Macula-centered. 50° FOV — 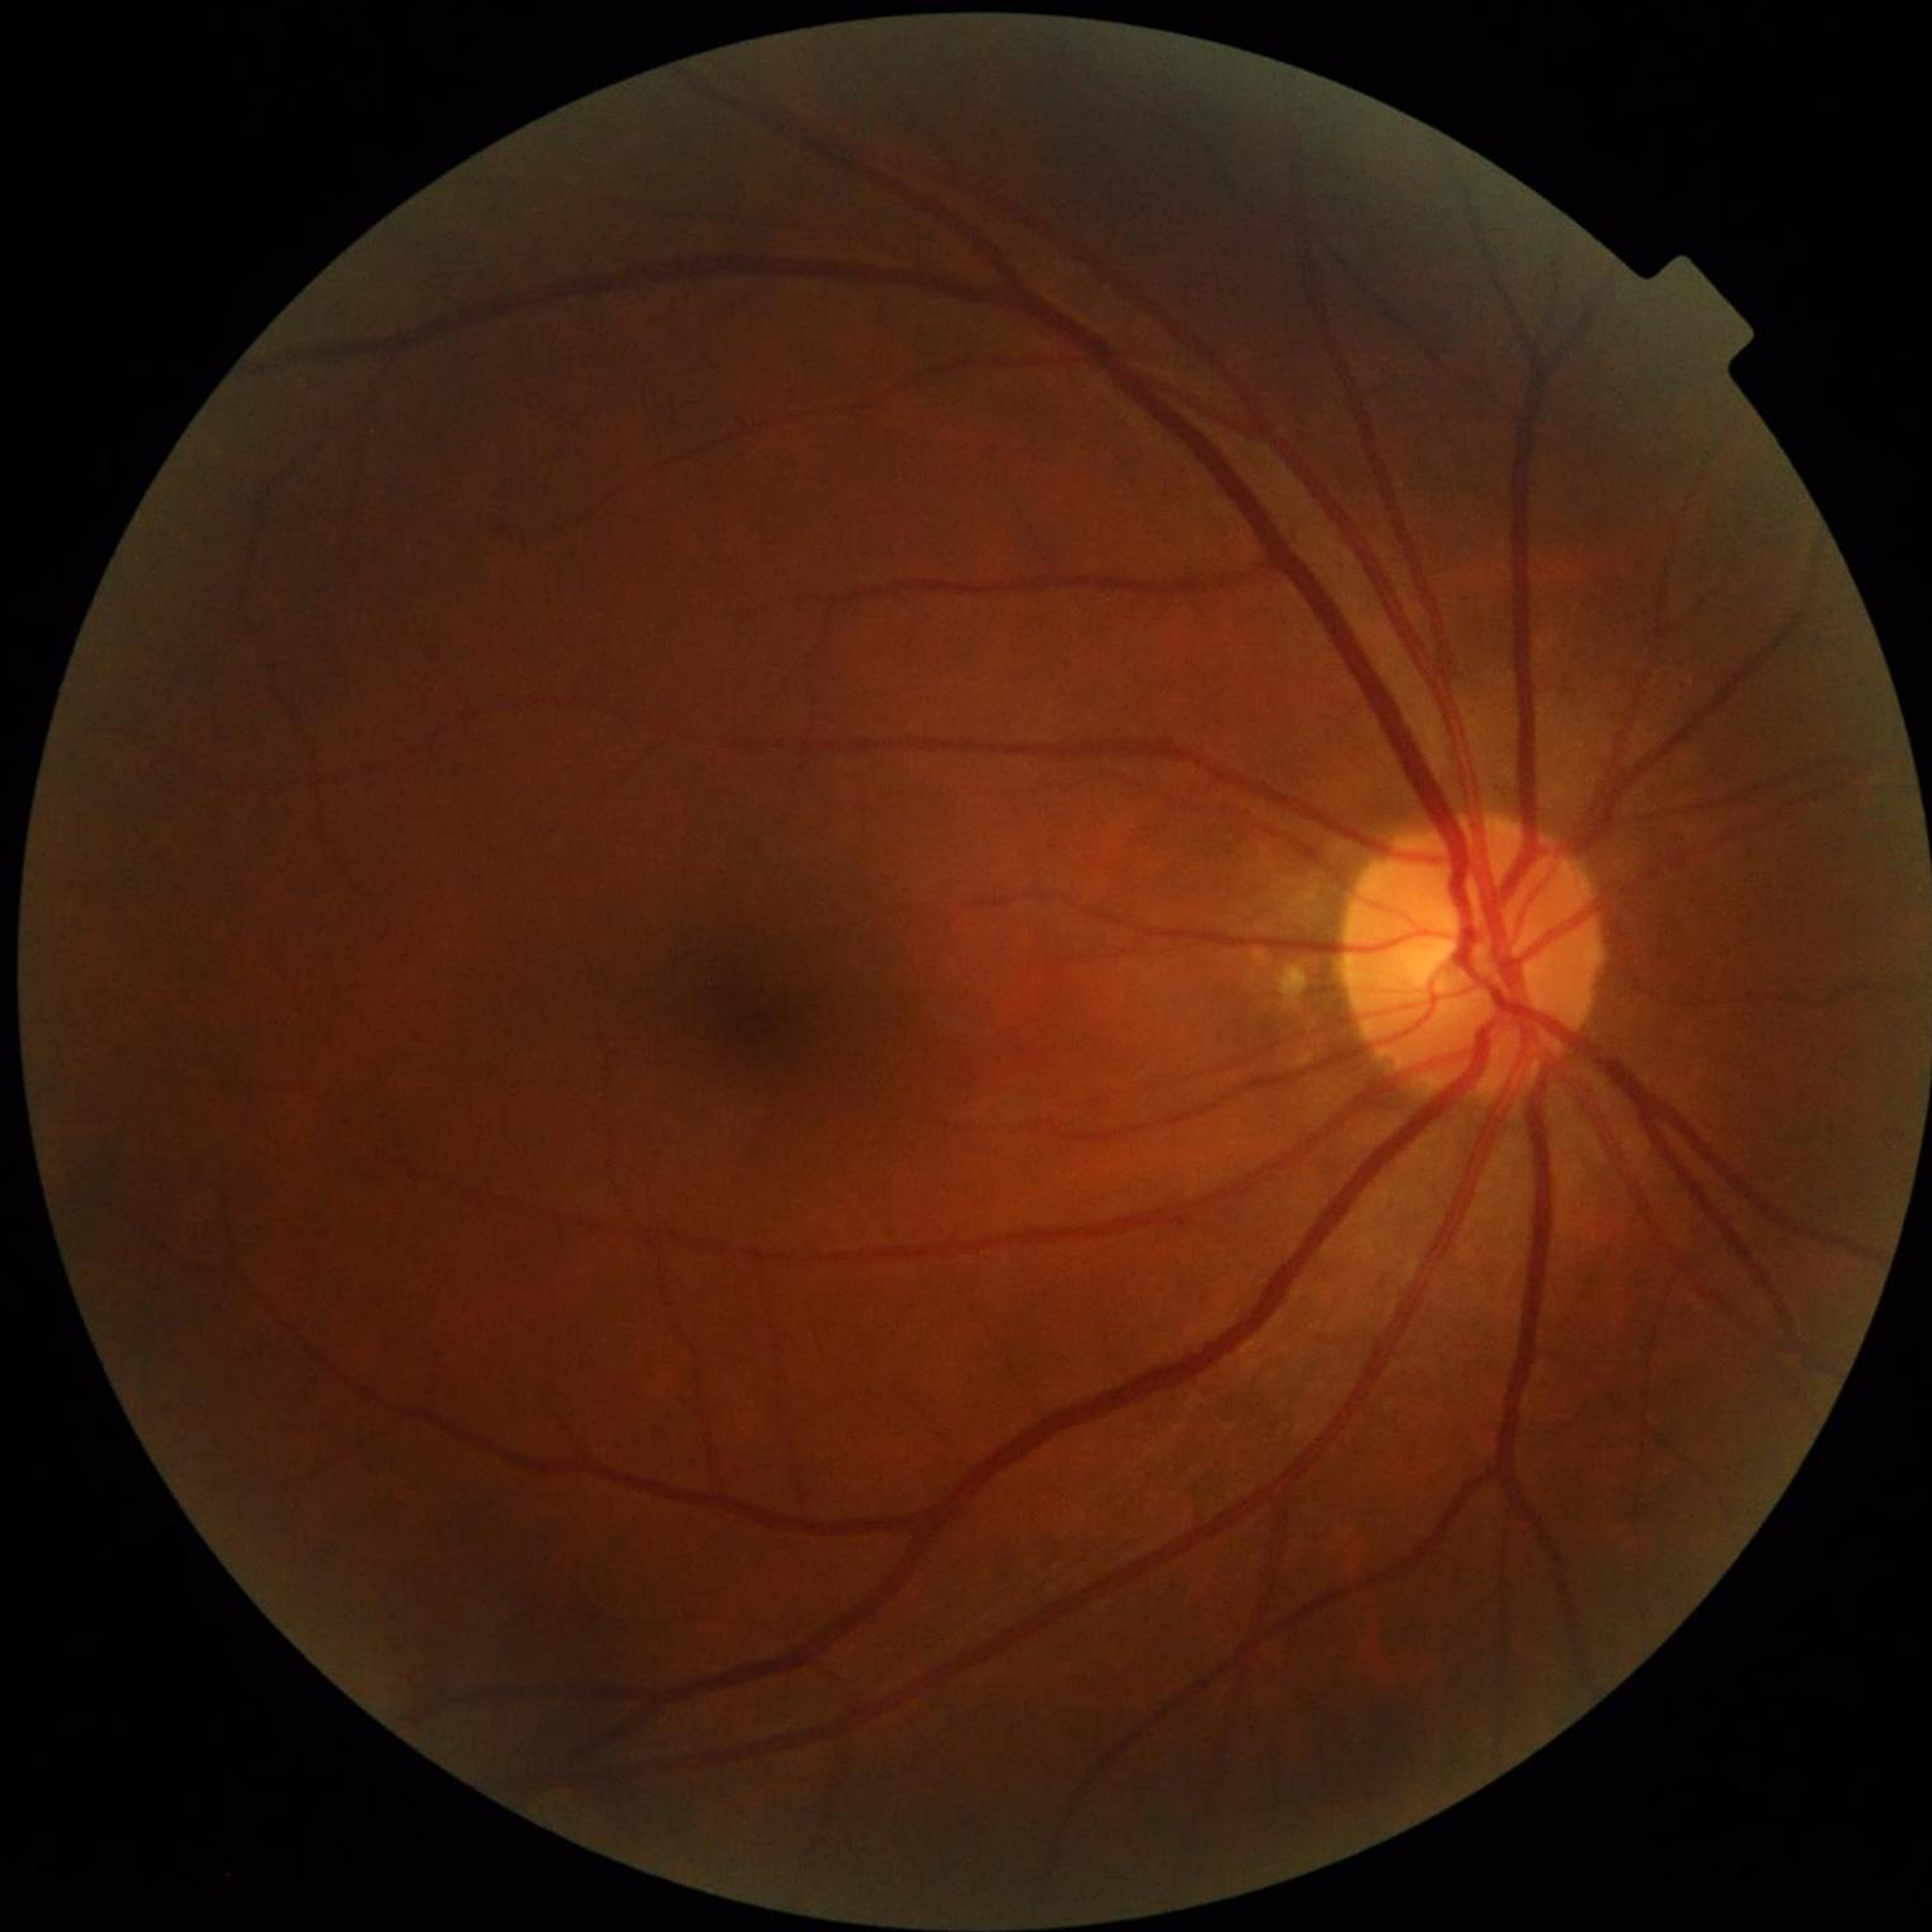

Color fundus photo from a control patient without diagnosed retinal disease.